45-degree field of view:
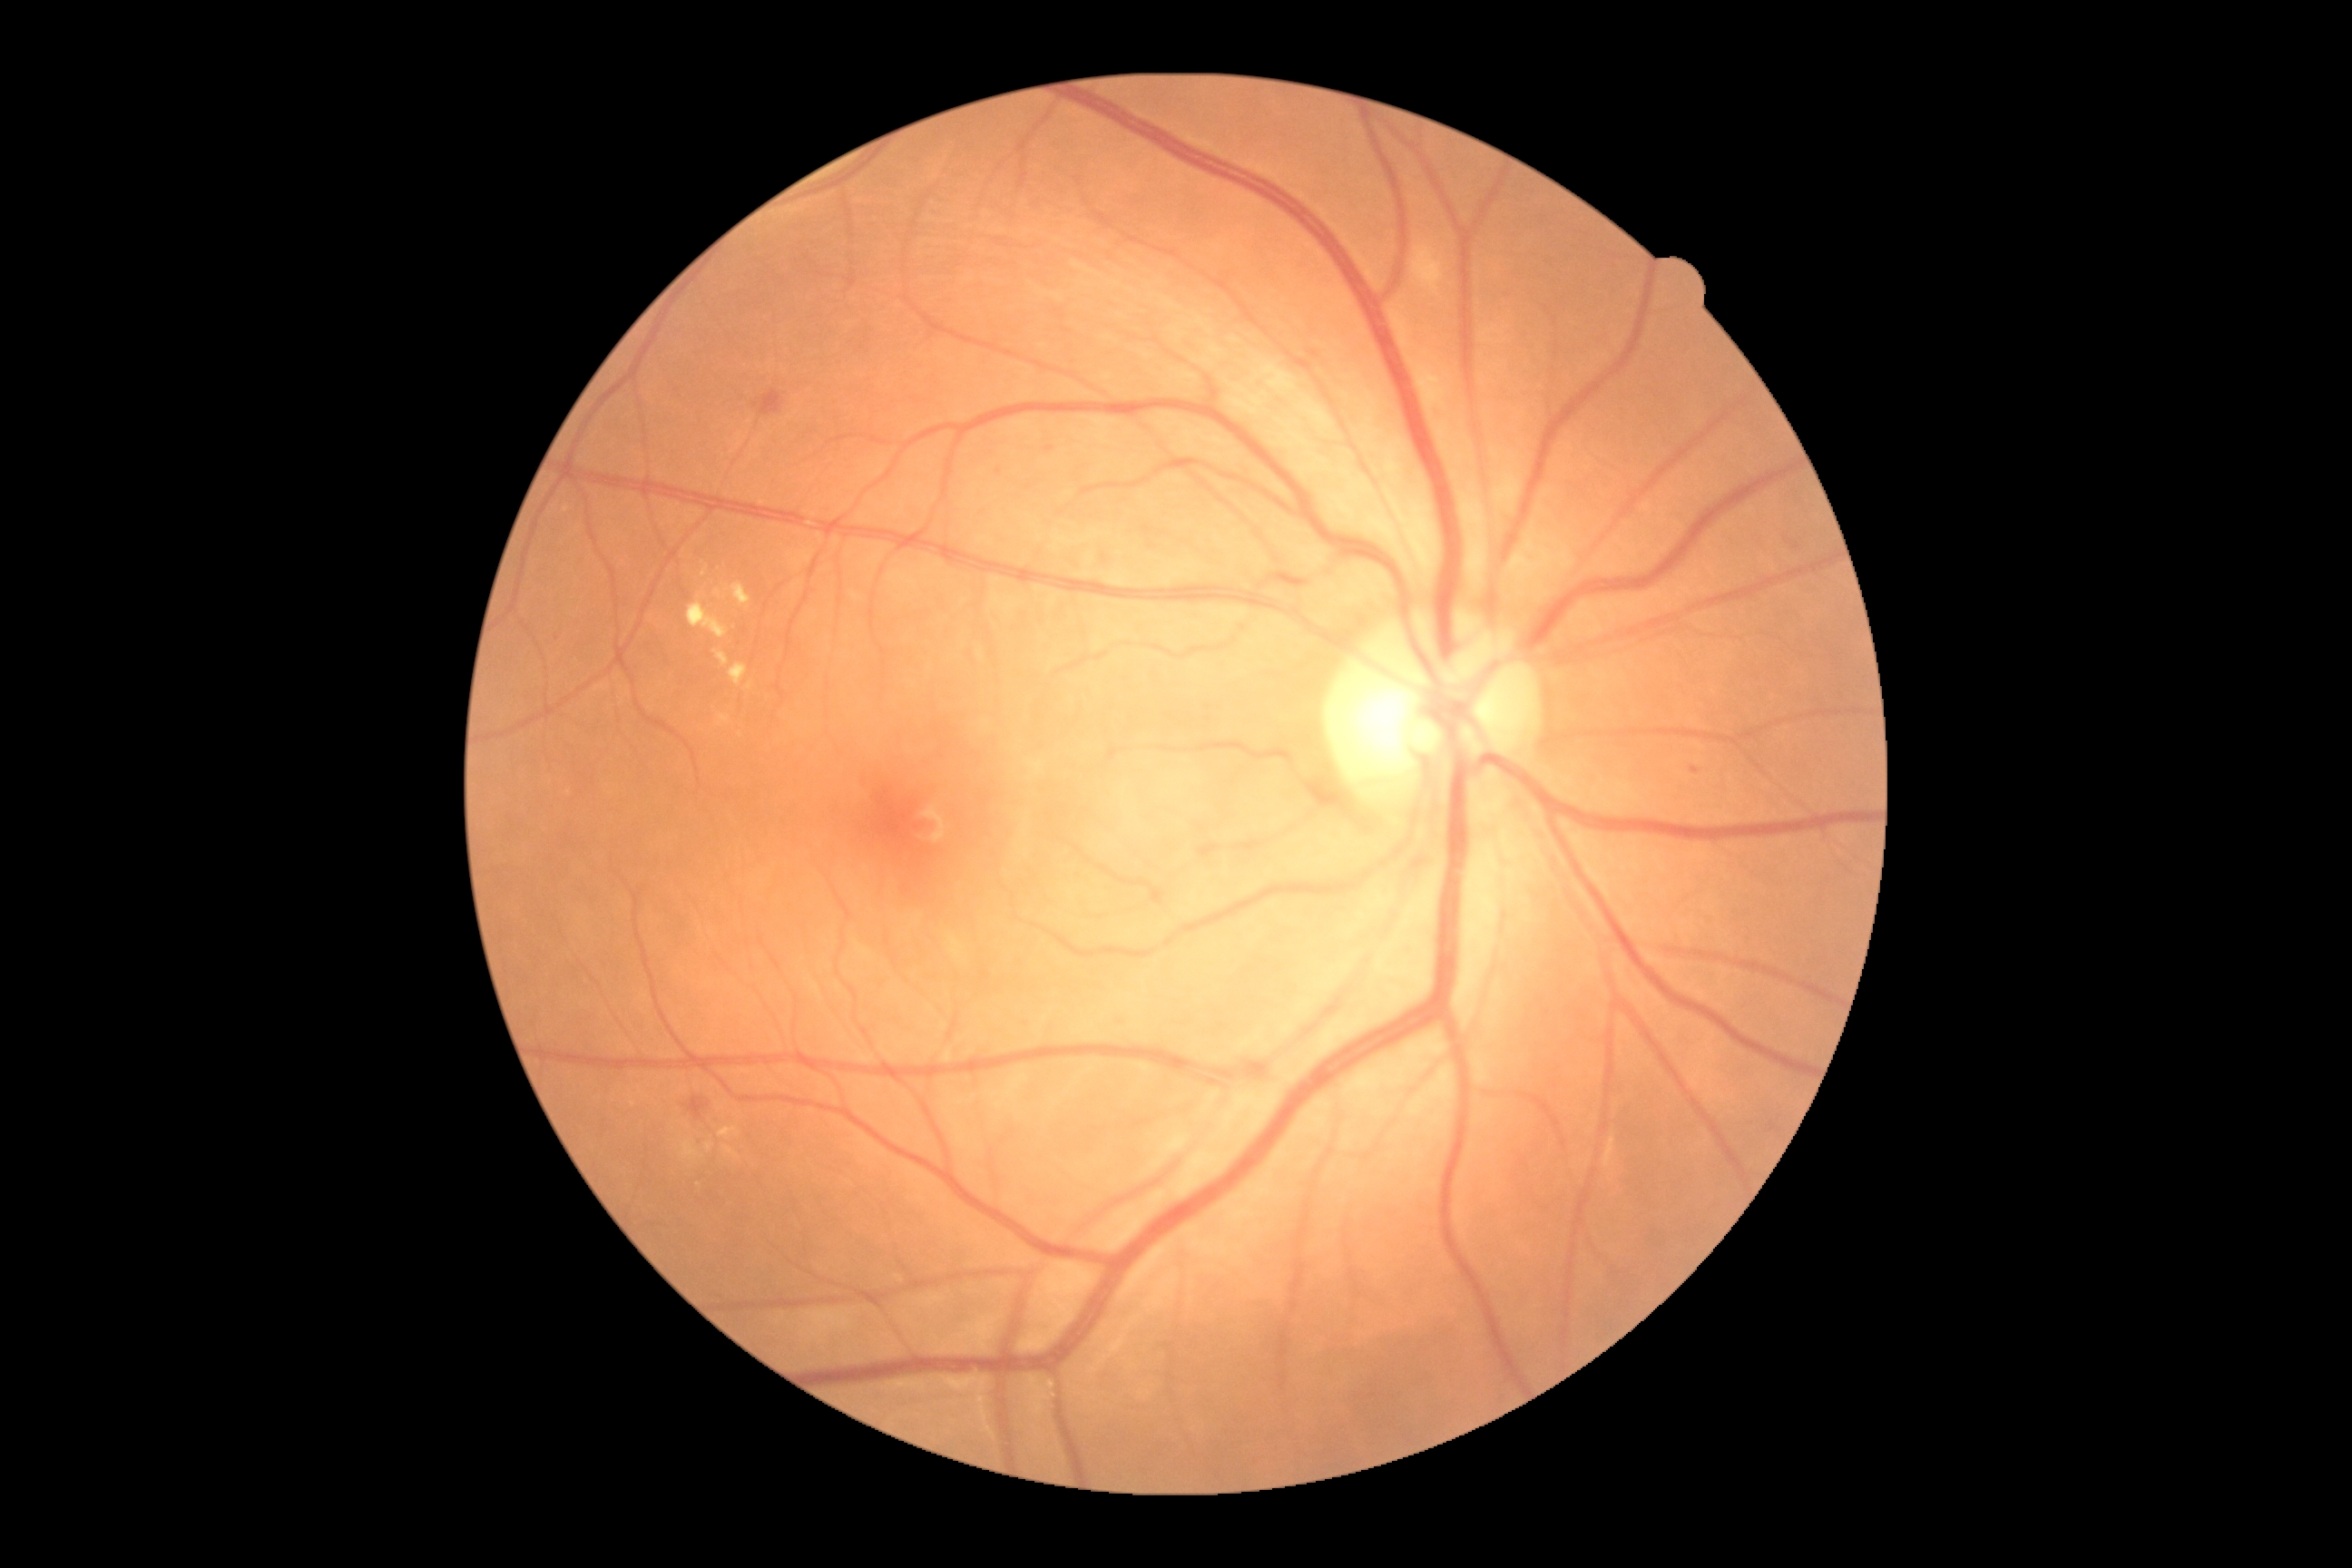

DR class: non-proliferative diabetic retinopathy.
Diabetic retinopathy (DR): 2.